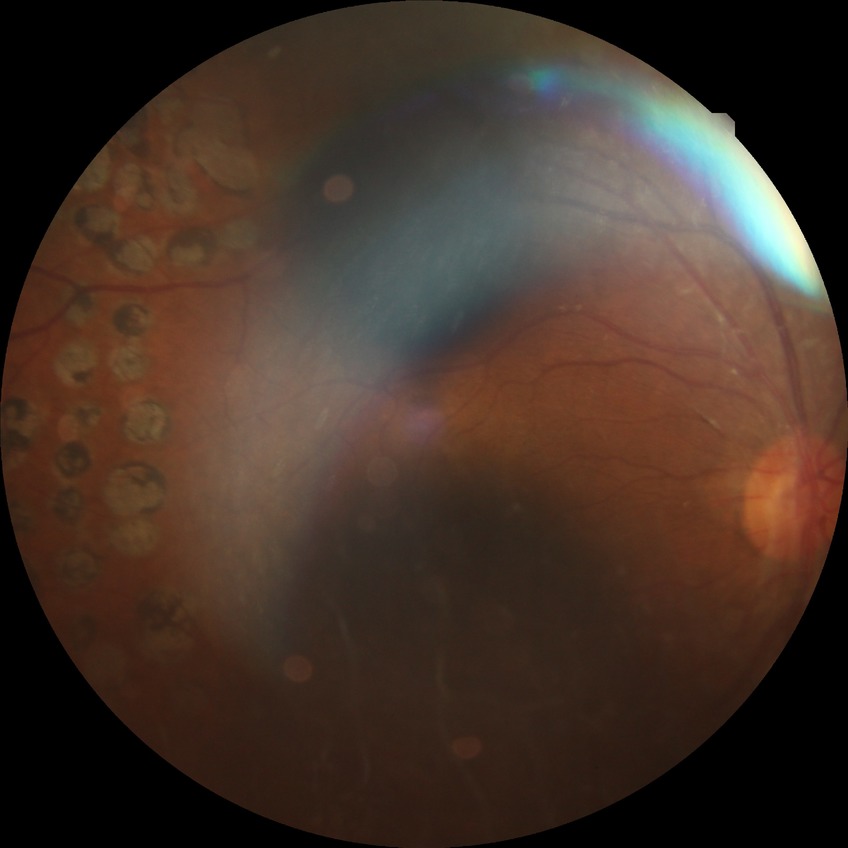
davis_grade: proliferative diabetic retinopathy (PDR)